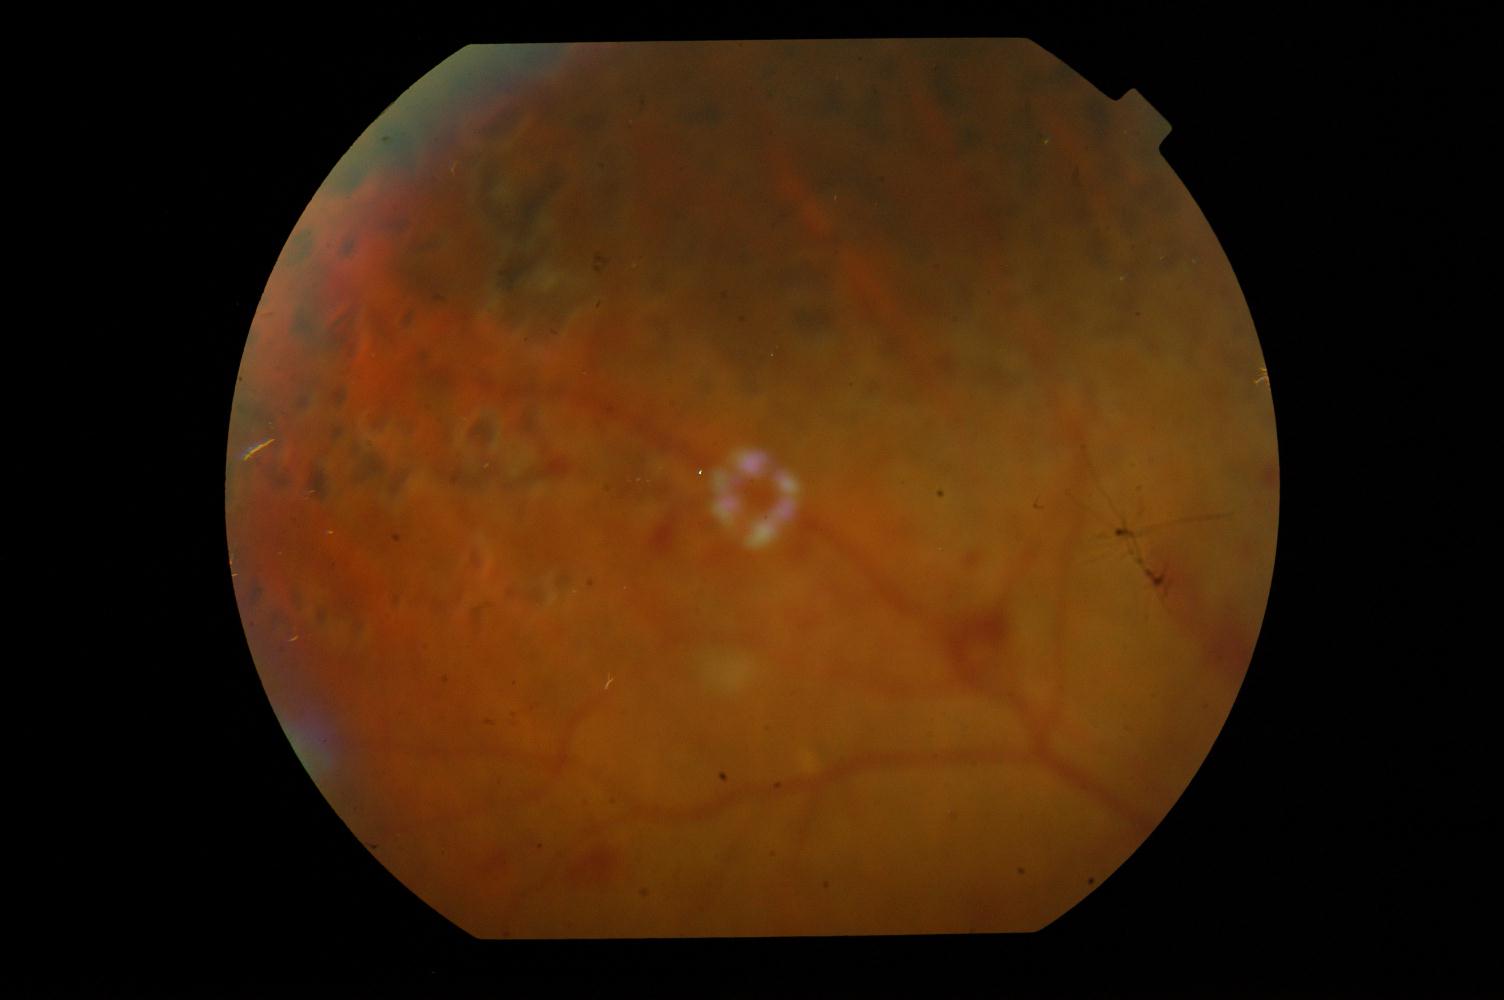

Findings: diabetic retinopathy (DR).